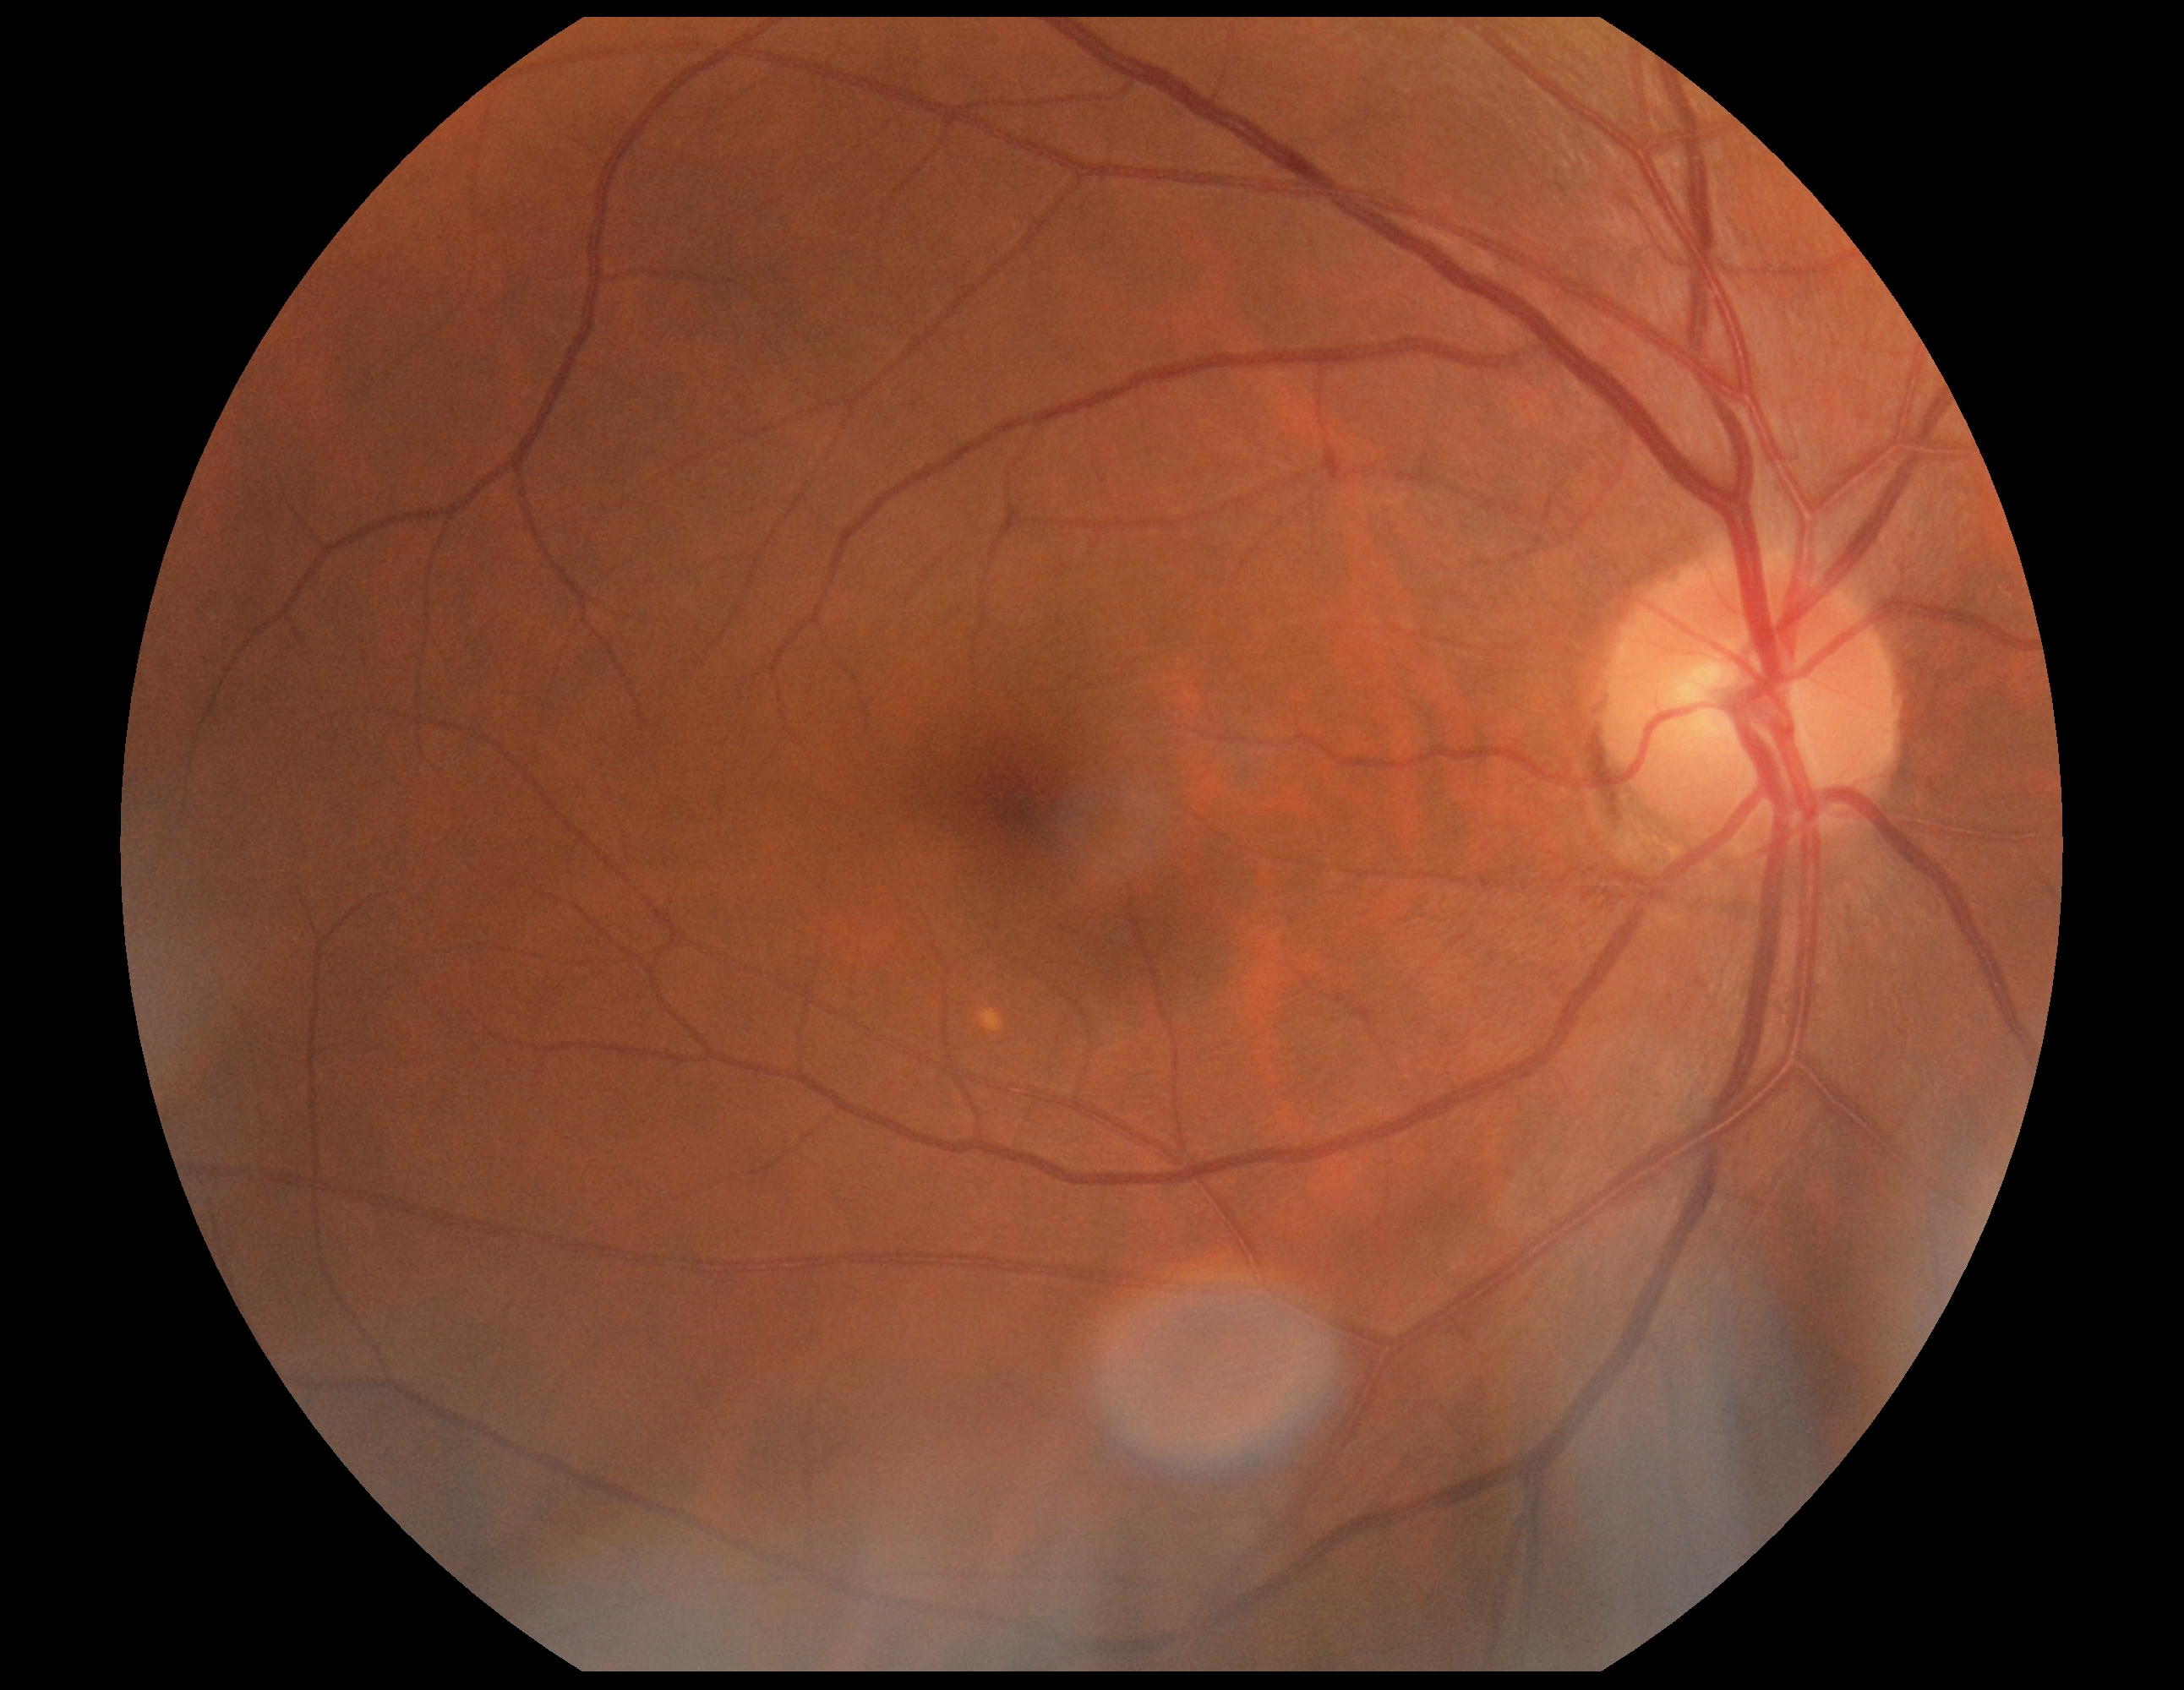

DR: 0.